Retinal fundus photograph · 848x848 · FOV: 45 degrees · diabetic retinopathy graded by the modified Davis classification:
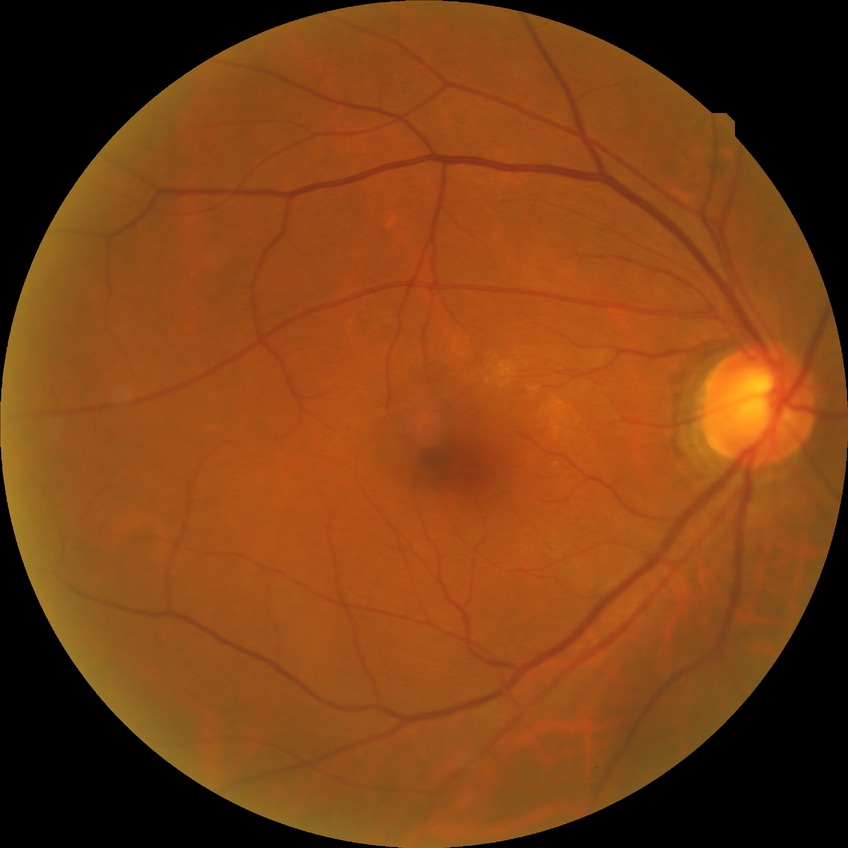

modified Davis grading@no diabetic retinopathy.